2346x1568: 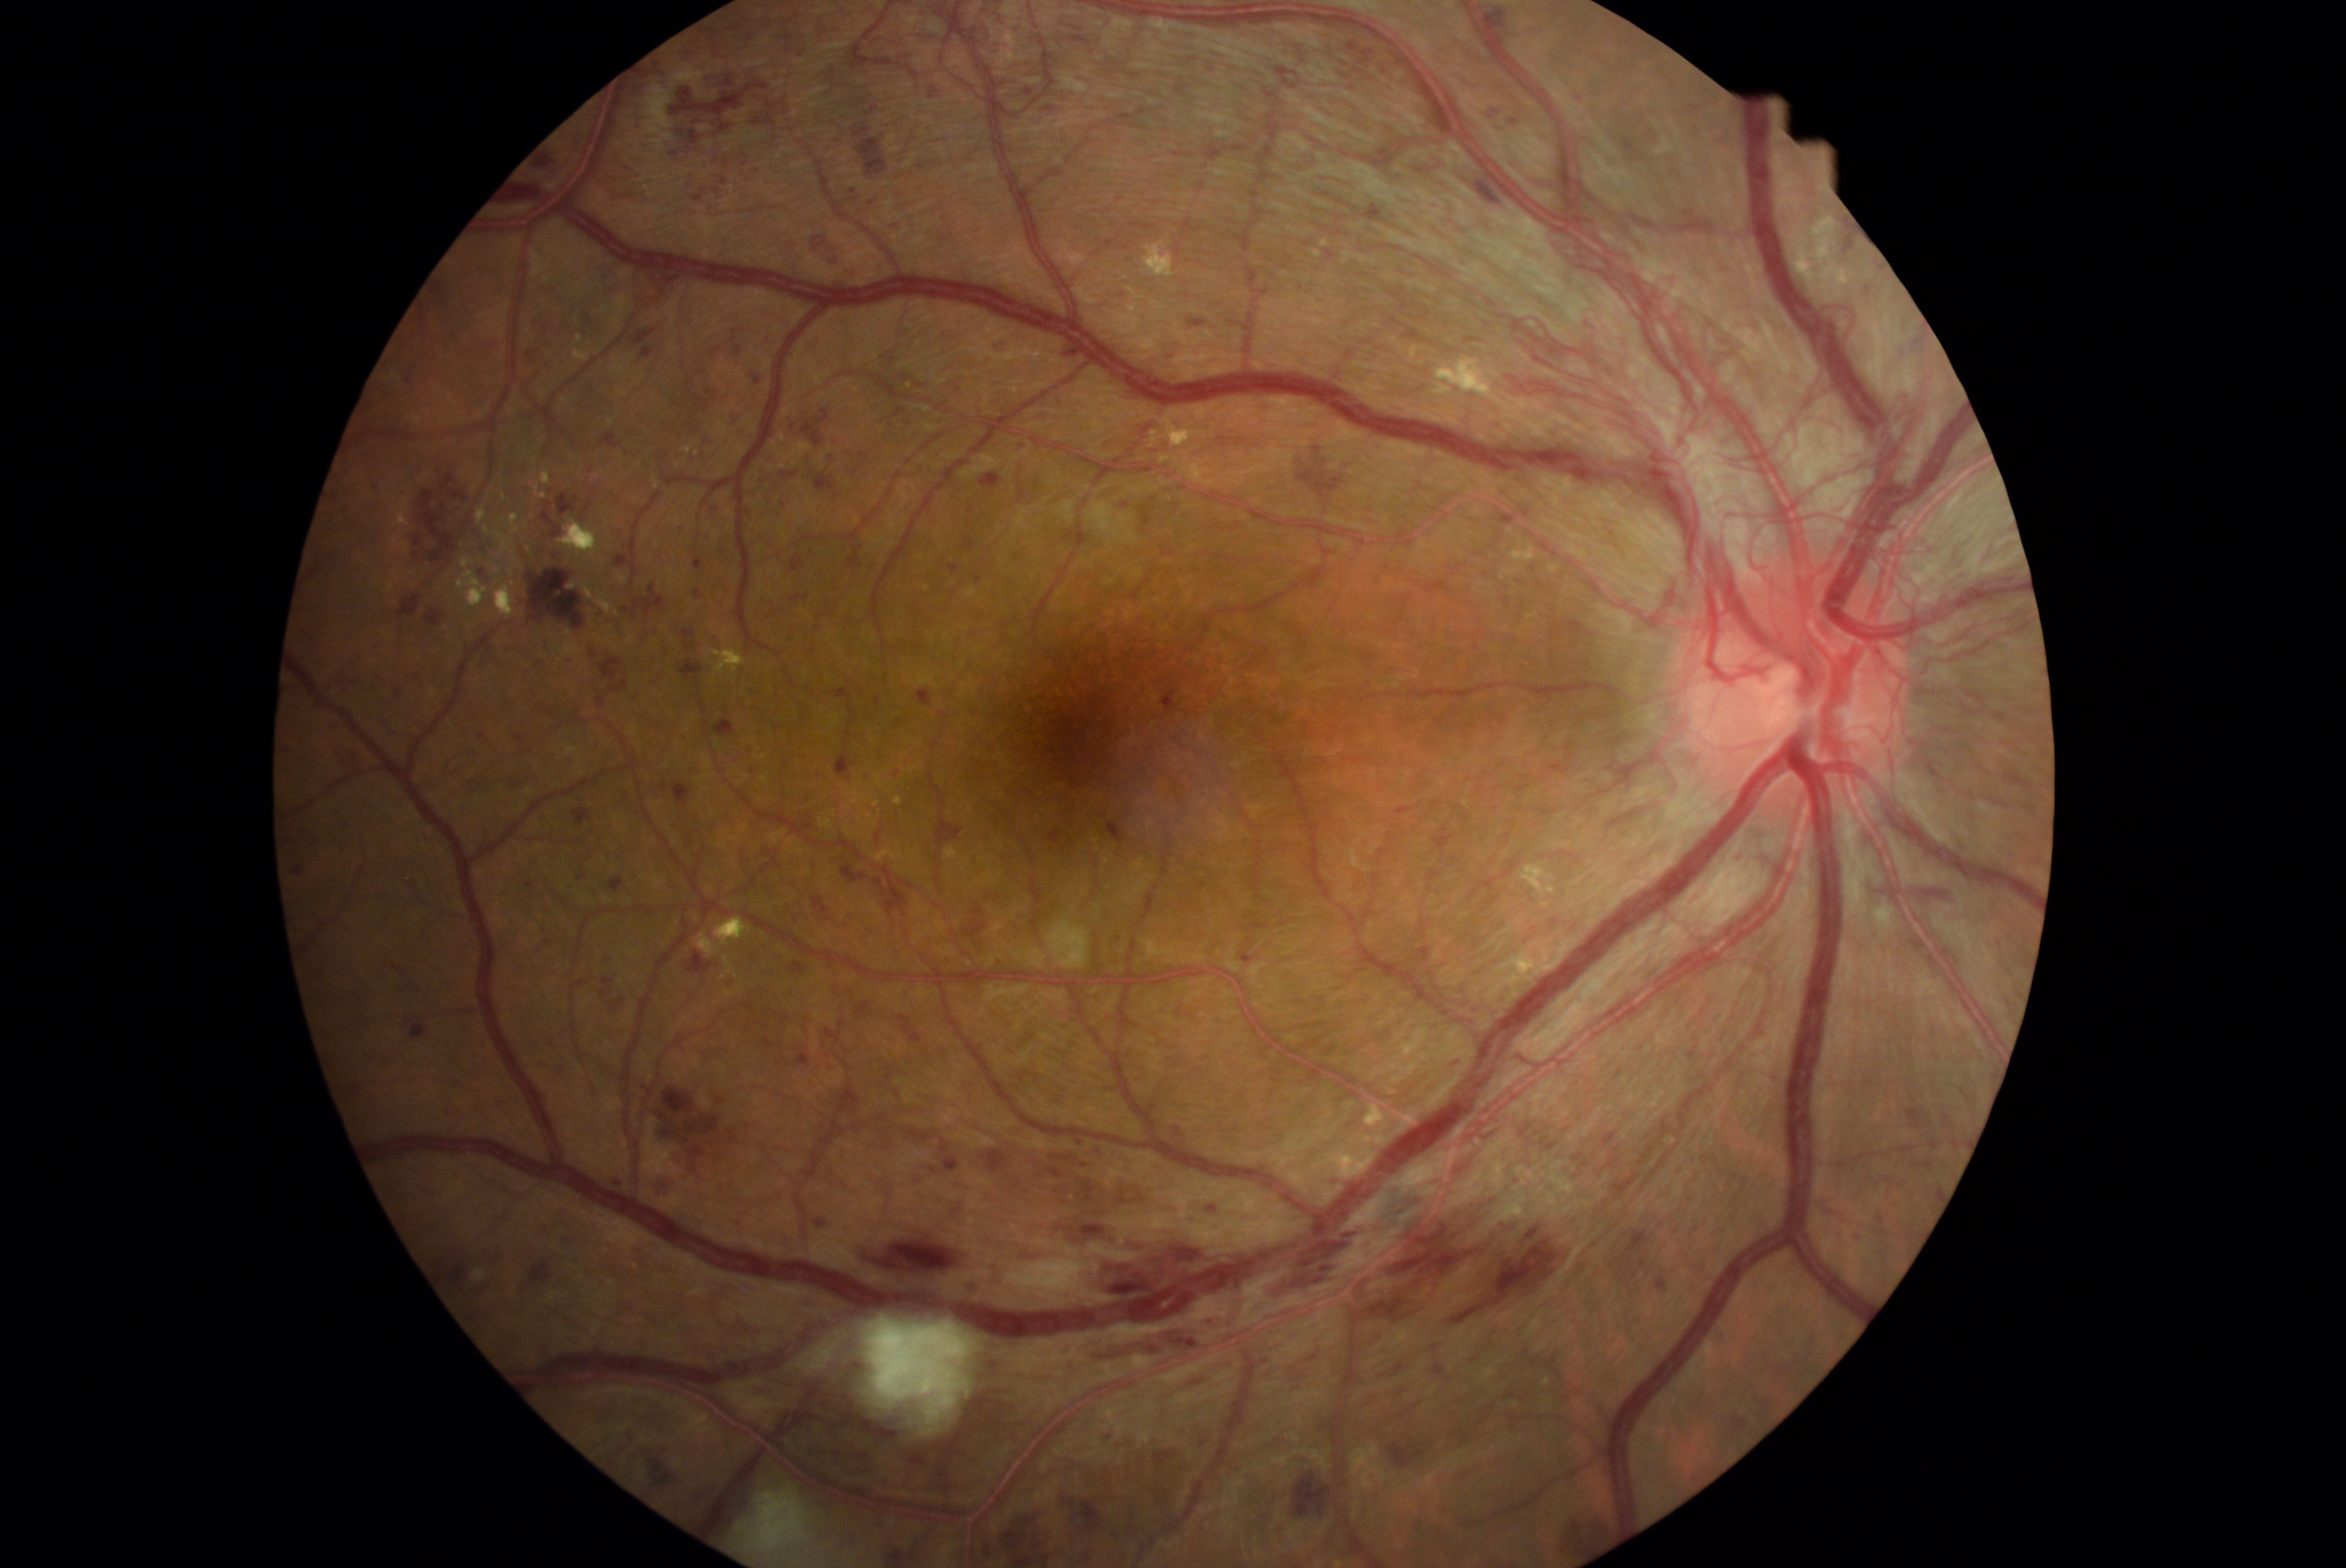

DR grade is 4 — neovascularization and/or vitreous/pre-retinal hemorrhage.
HEs include (689,423,699,434); (1469,637,1480,658); (794,962,807,975); (923,84,940,101); (1100,1431,1114,1450); (1036,1073,1044,1081); (506,176,556,208); (639,140,659,147); (1276,67,1298,90); (981,1506,1048,1552); (950,1196,968,1218); (405,456,493,568); (335,747,363,771); (876,695,884,706); (1872,1172,1906,1202); (612,1177,628,1189); (1431,830,1448,851).
Smaller HEs around {"x": 1870, "y": 288}; {"x": 945, "y": 1054}; {"x": 855, "y": 470}.